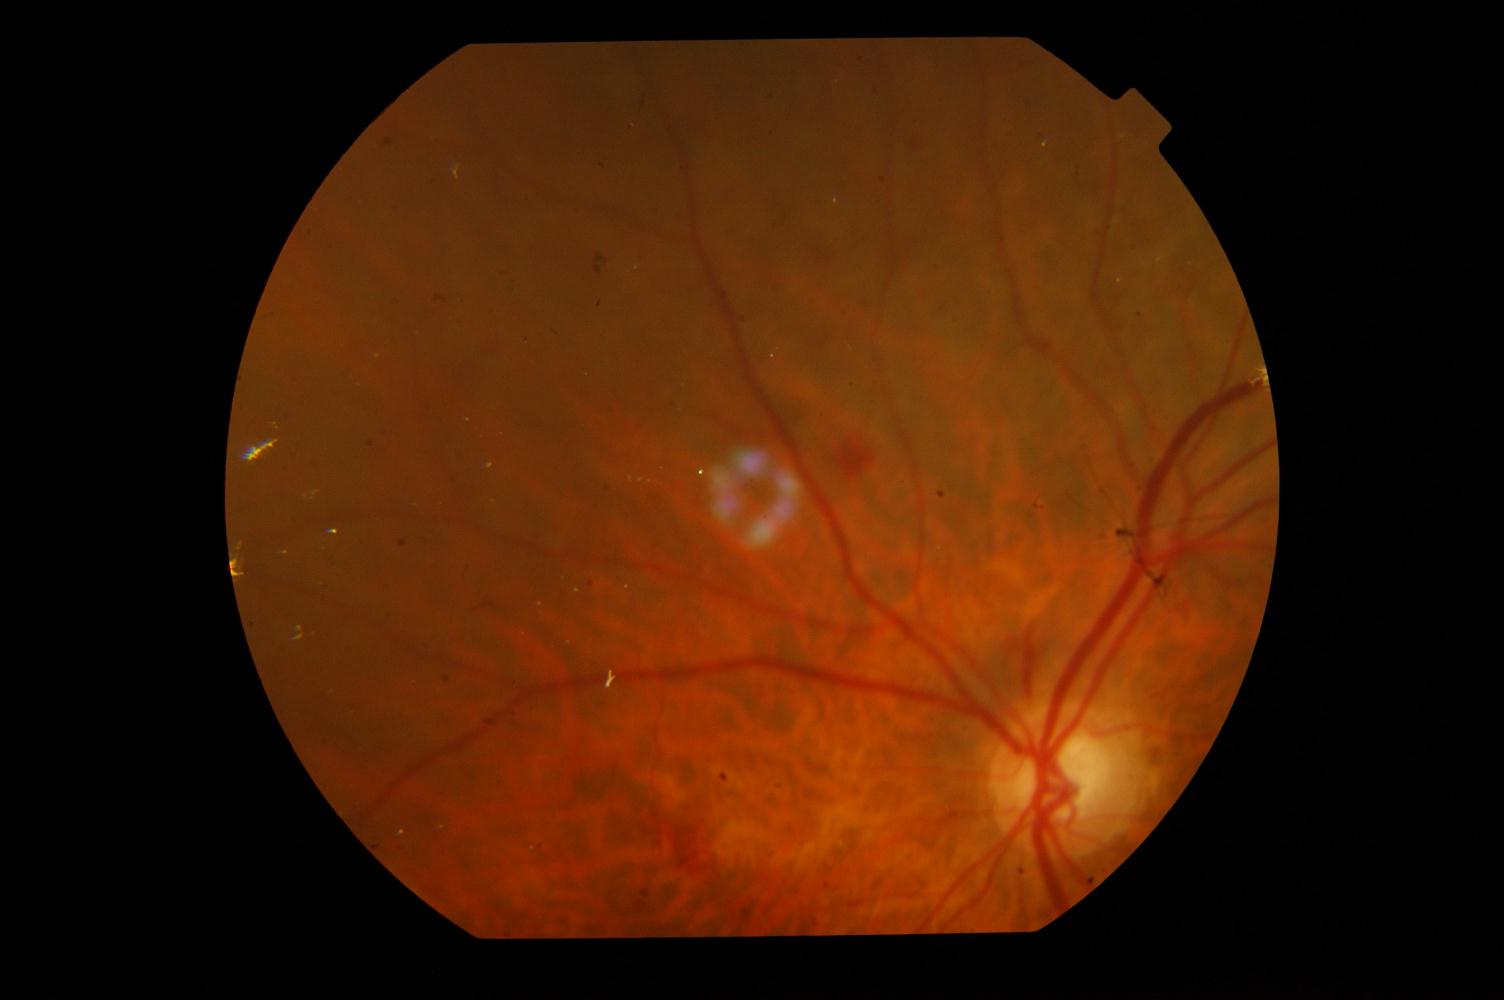

Diagnosis: diabetic retinopathy.